848 x 848 pixels, 45° FOV, nonmydriatic, diabetic retinopathy graded by the modified Davis classification.
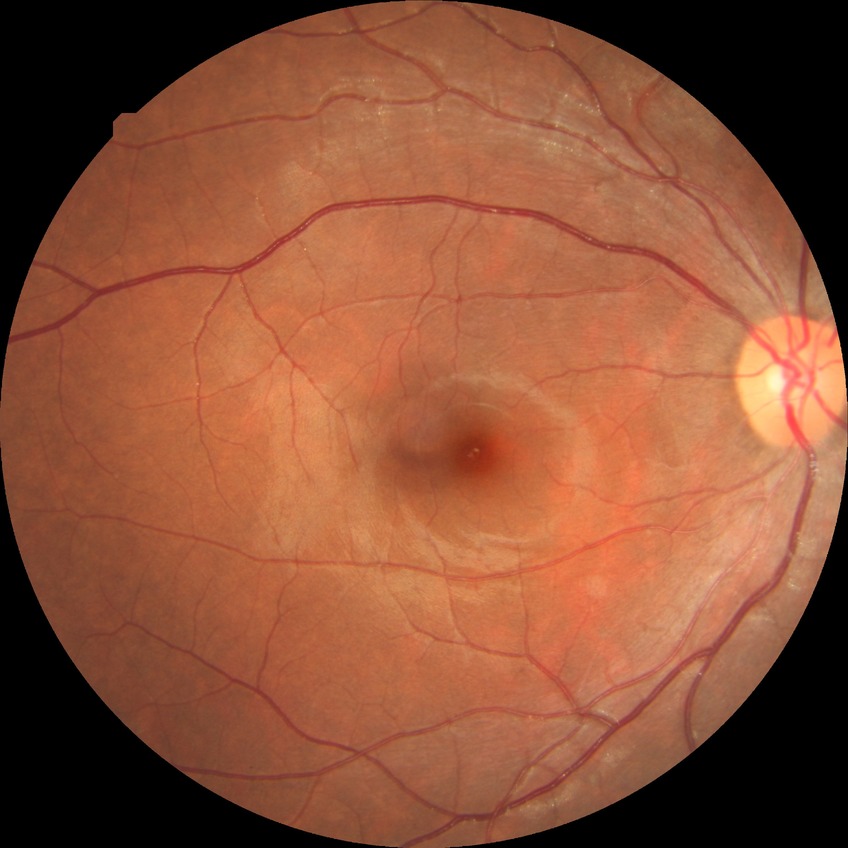
  davis_grade: no diabetic retinopathy (NDR)